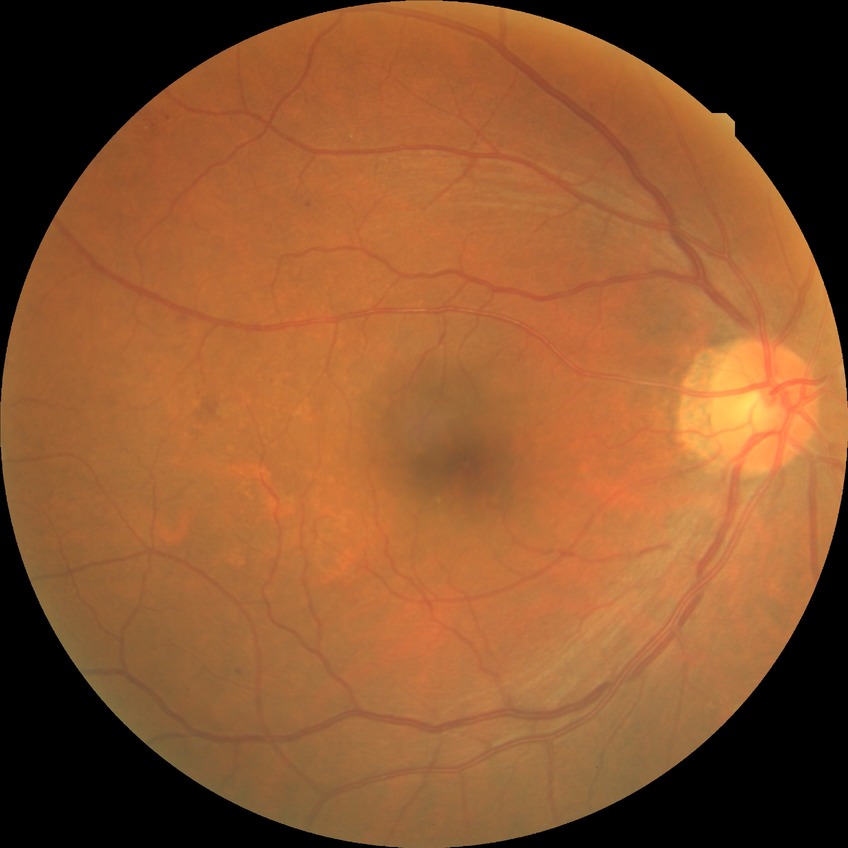
Diabetic retinopathy (DR): SDR (simple diabetic retinopathy).